45° field of view:
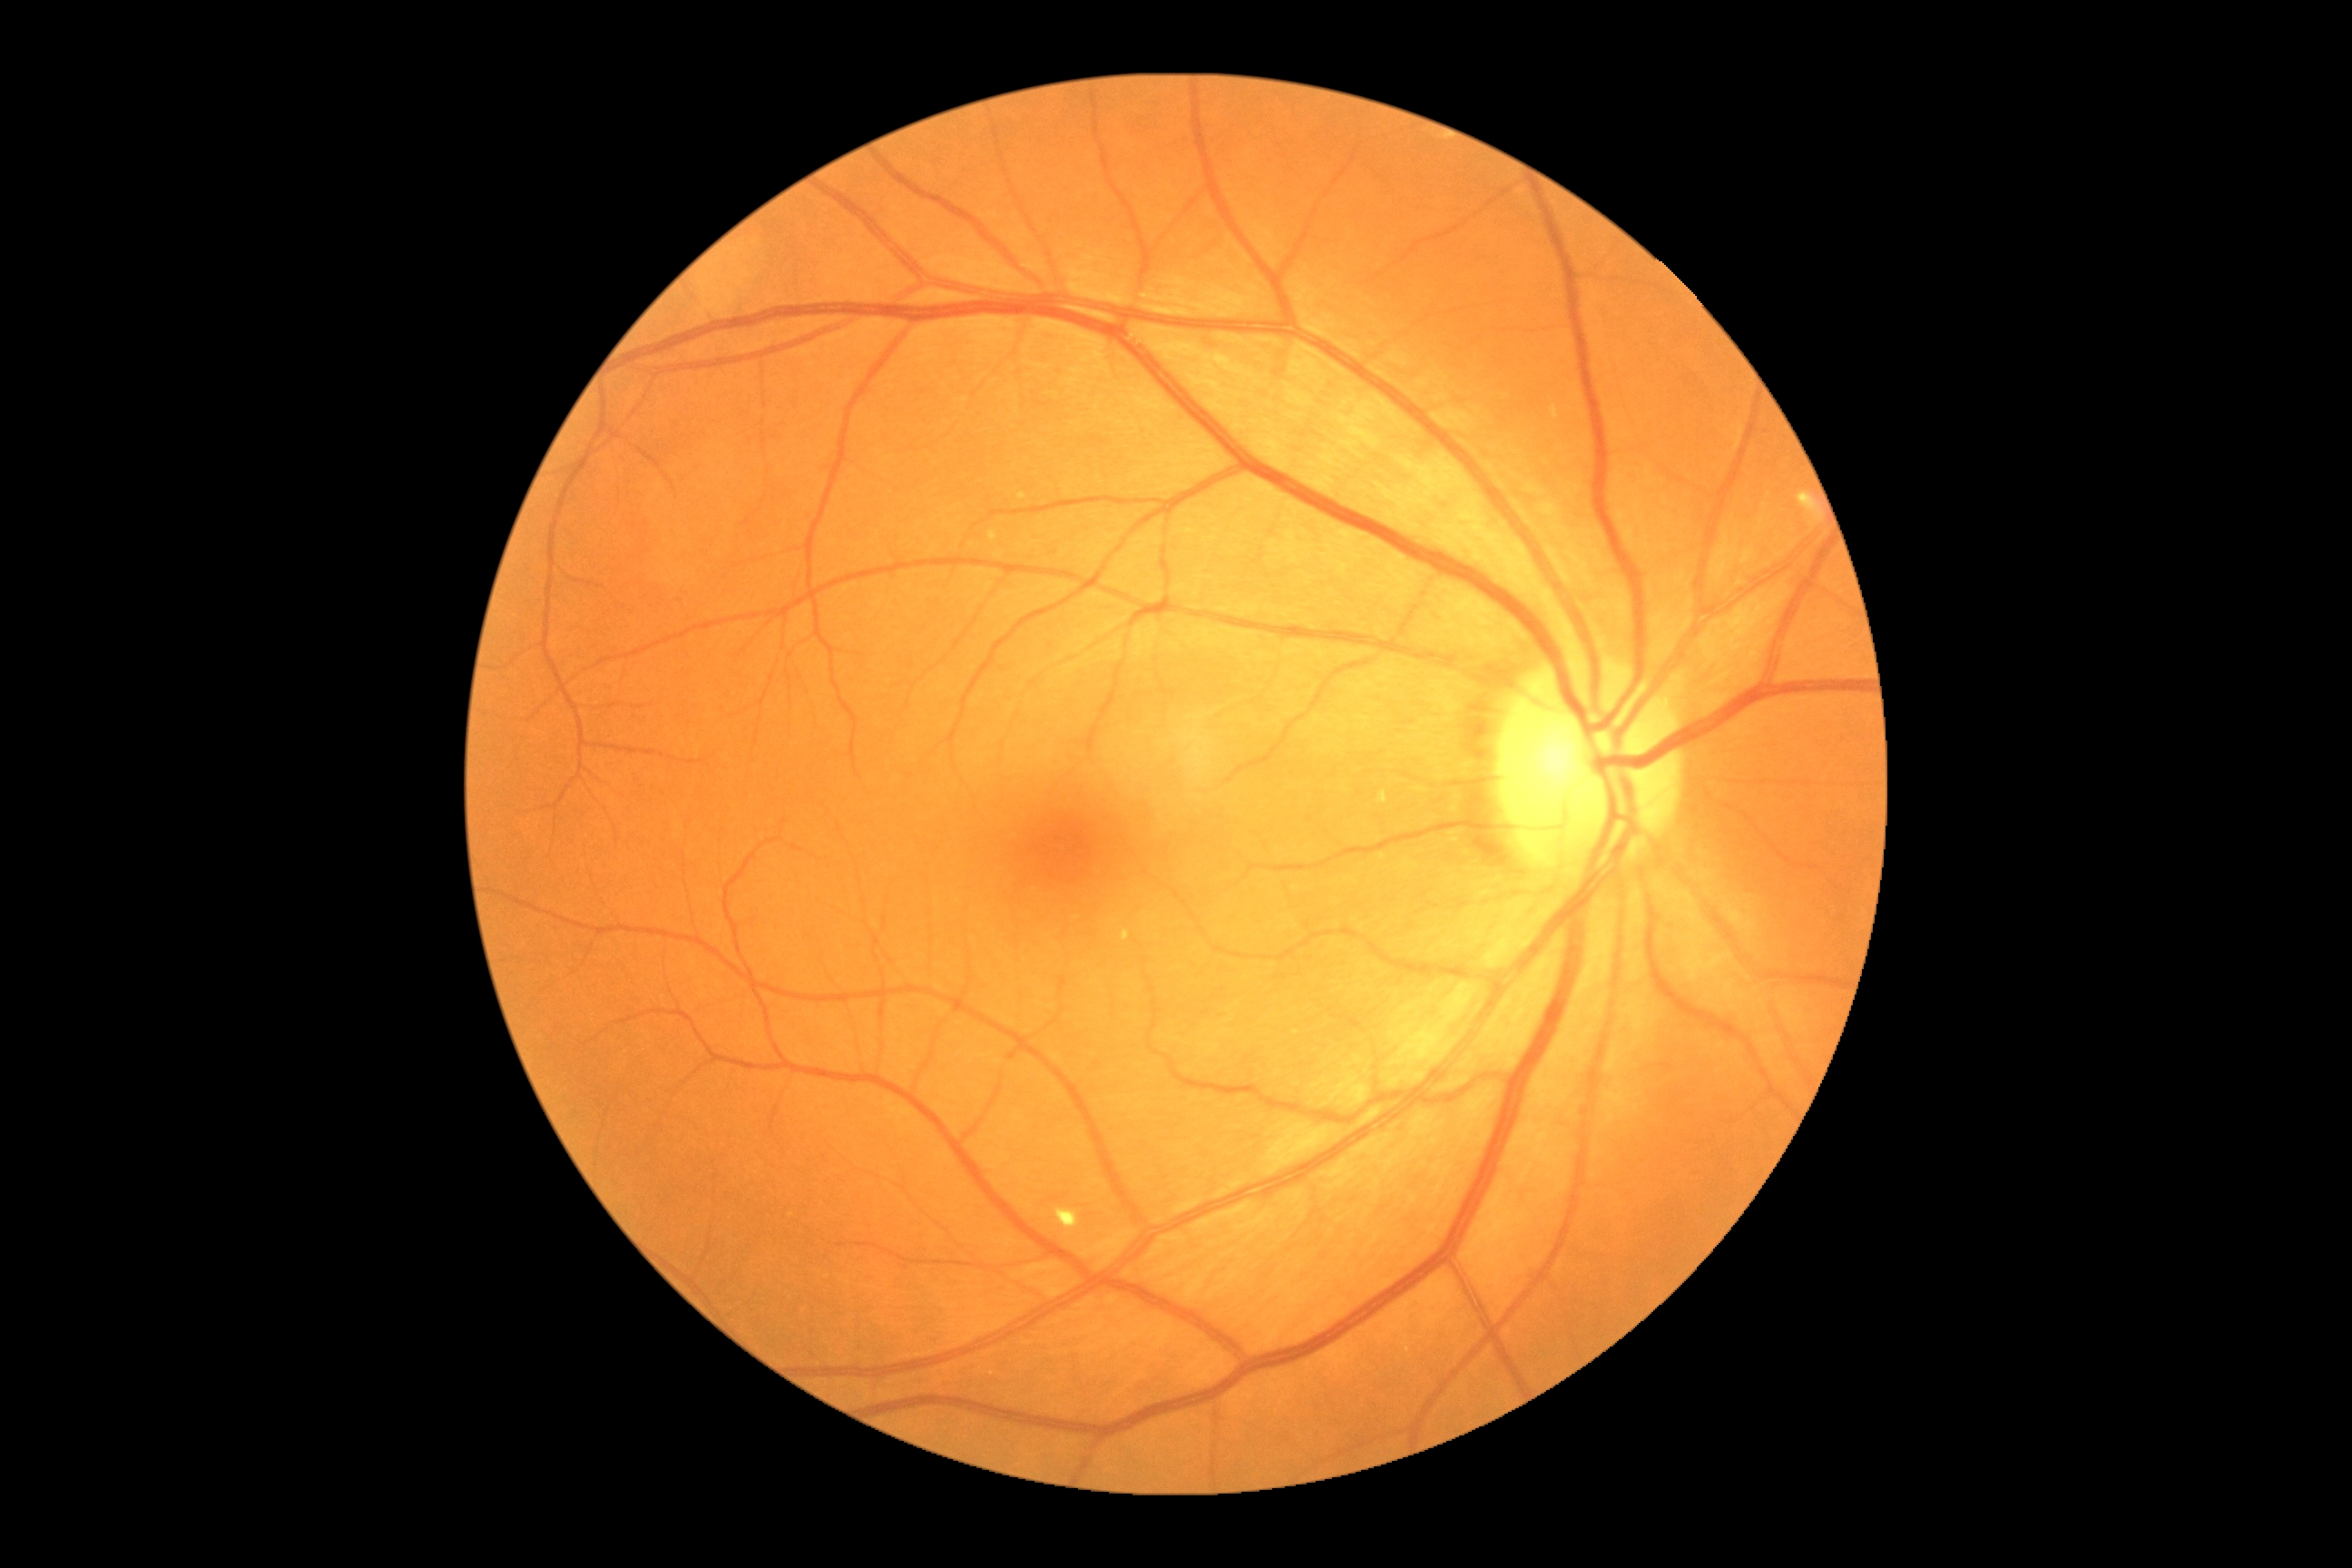
DR stage is 2/4.